Fundus photo. 45° field of view — 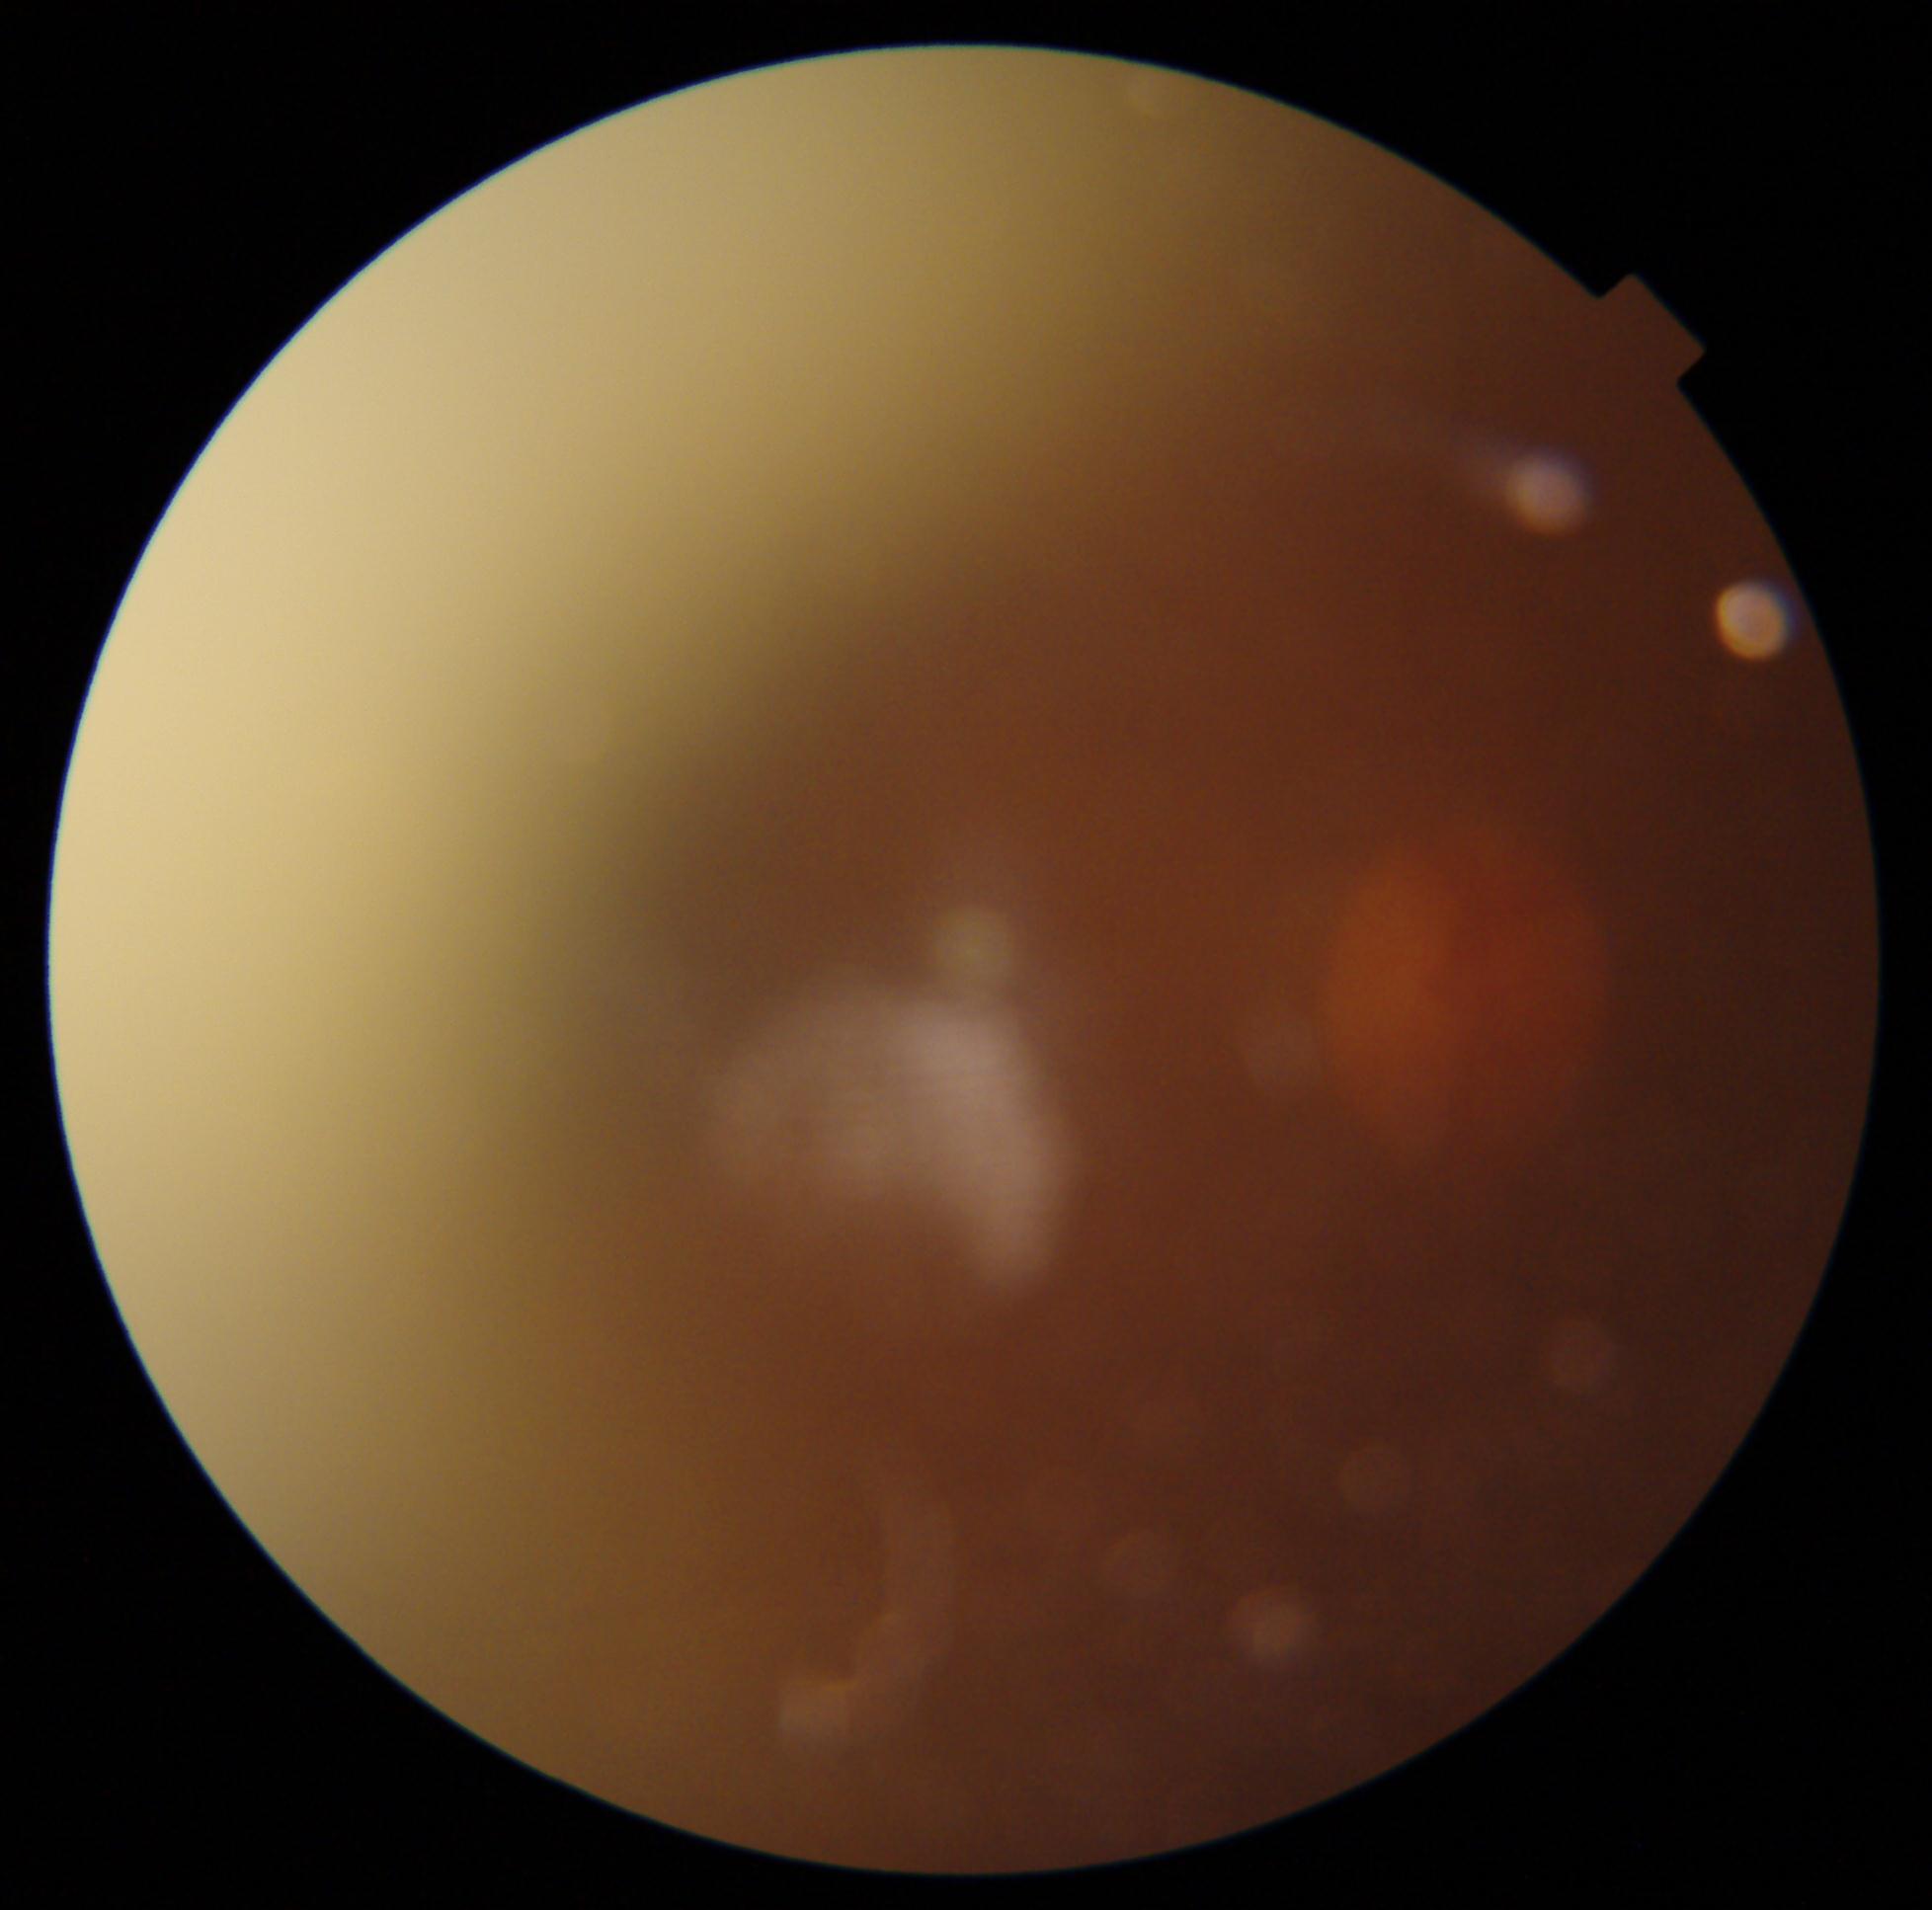
DR stage: ungradable due to poor image quality.